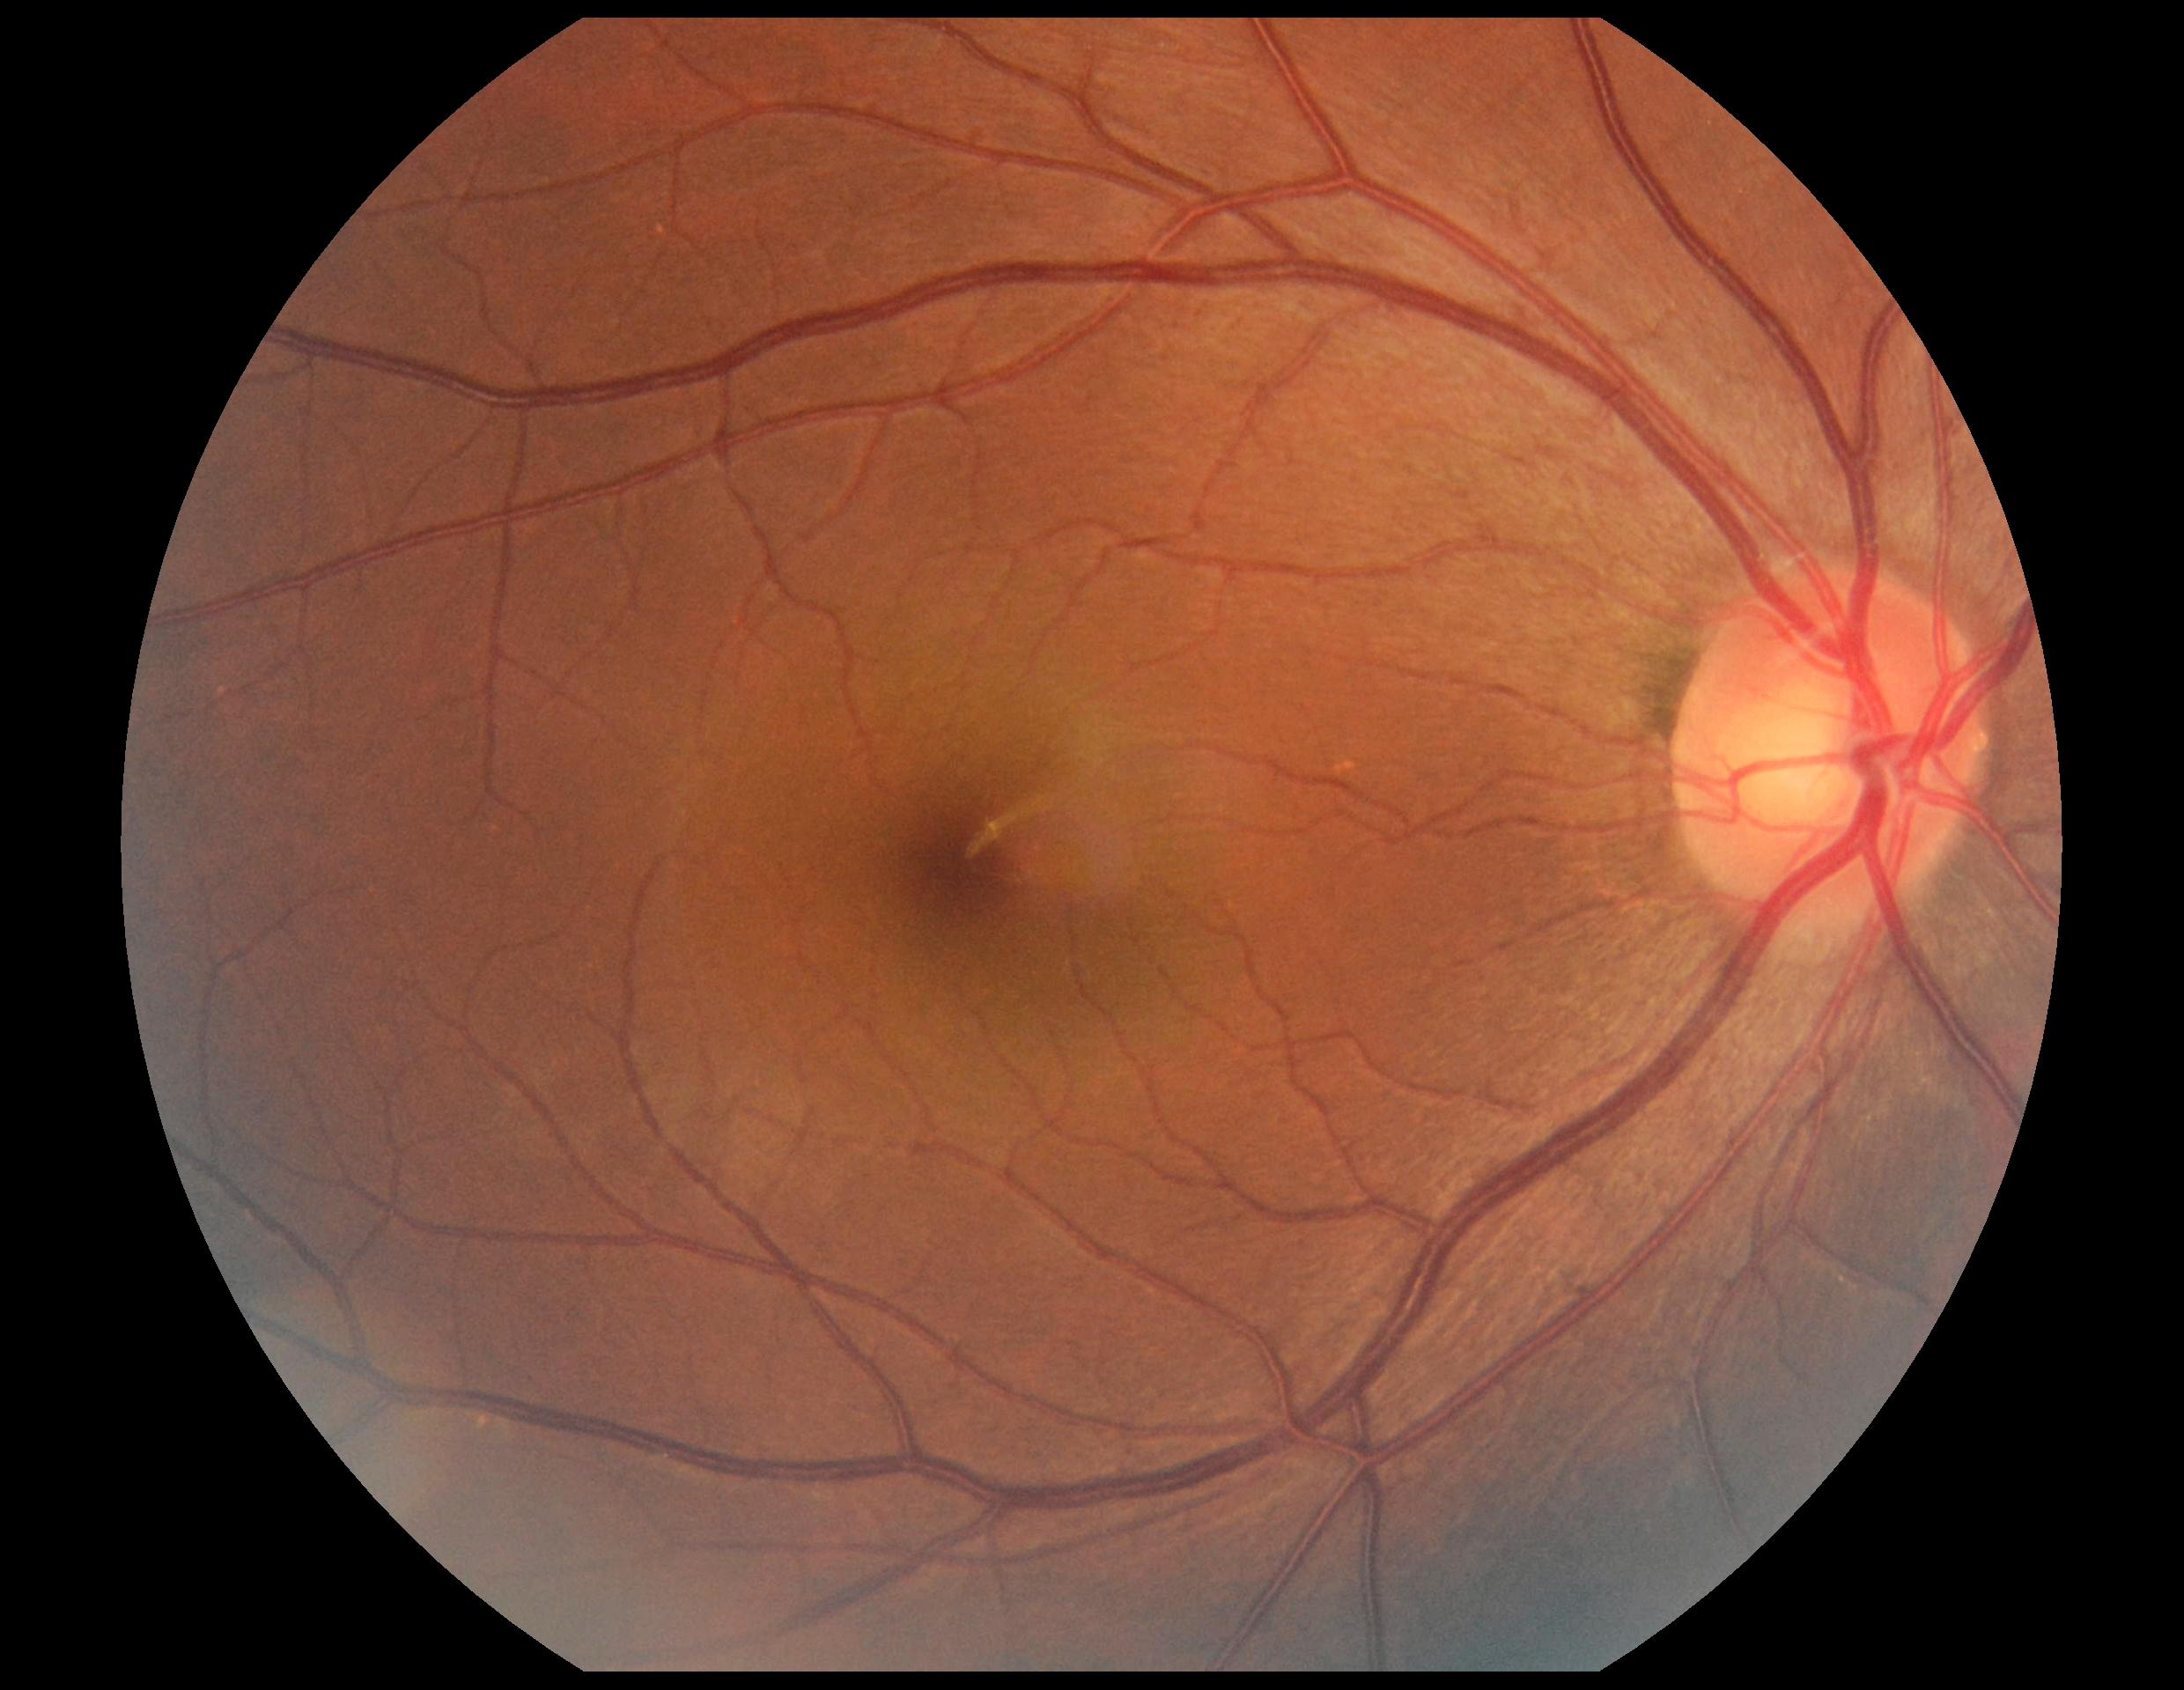 Retinopathy grade: 0 (no apparent retinopathy).